Without pupil dilation; 45° FOV; acquired with a NIDEK AFC-230; 848 x 848 pixels: 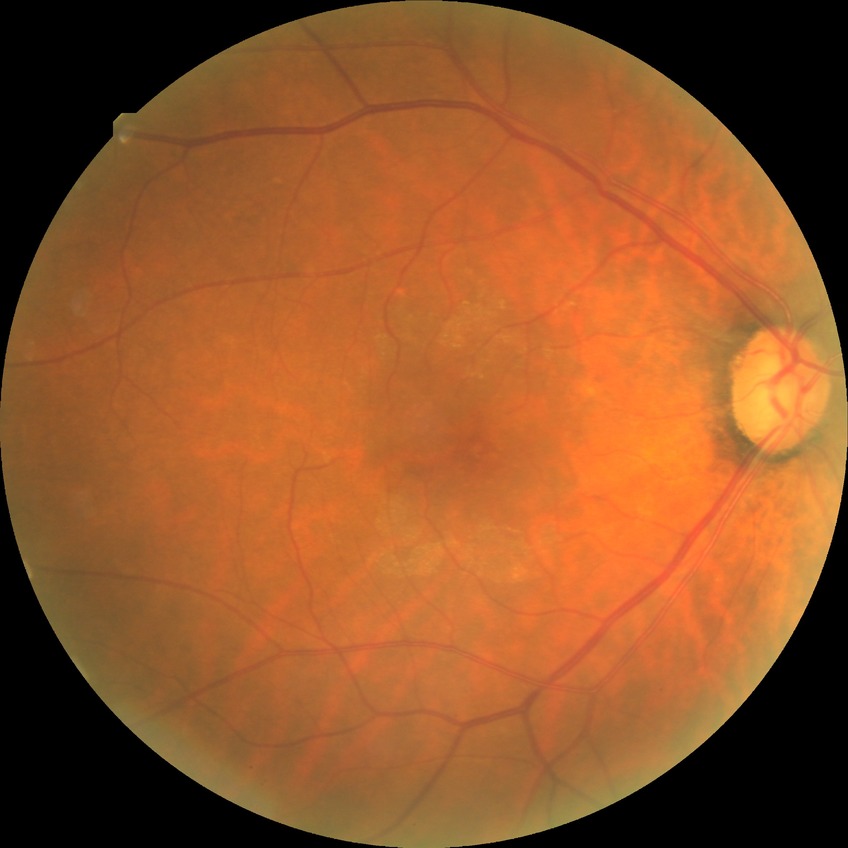
diabetic retinopathy (DR)@NDR (no diabetic retinopathy).